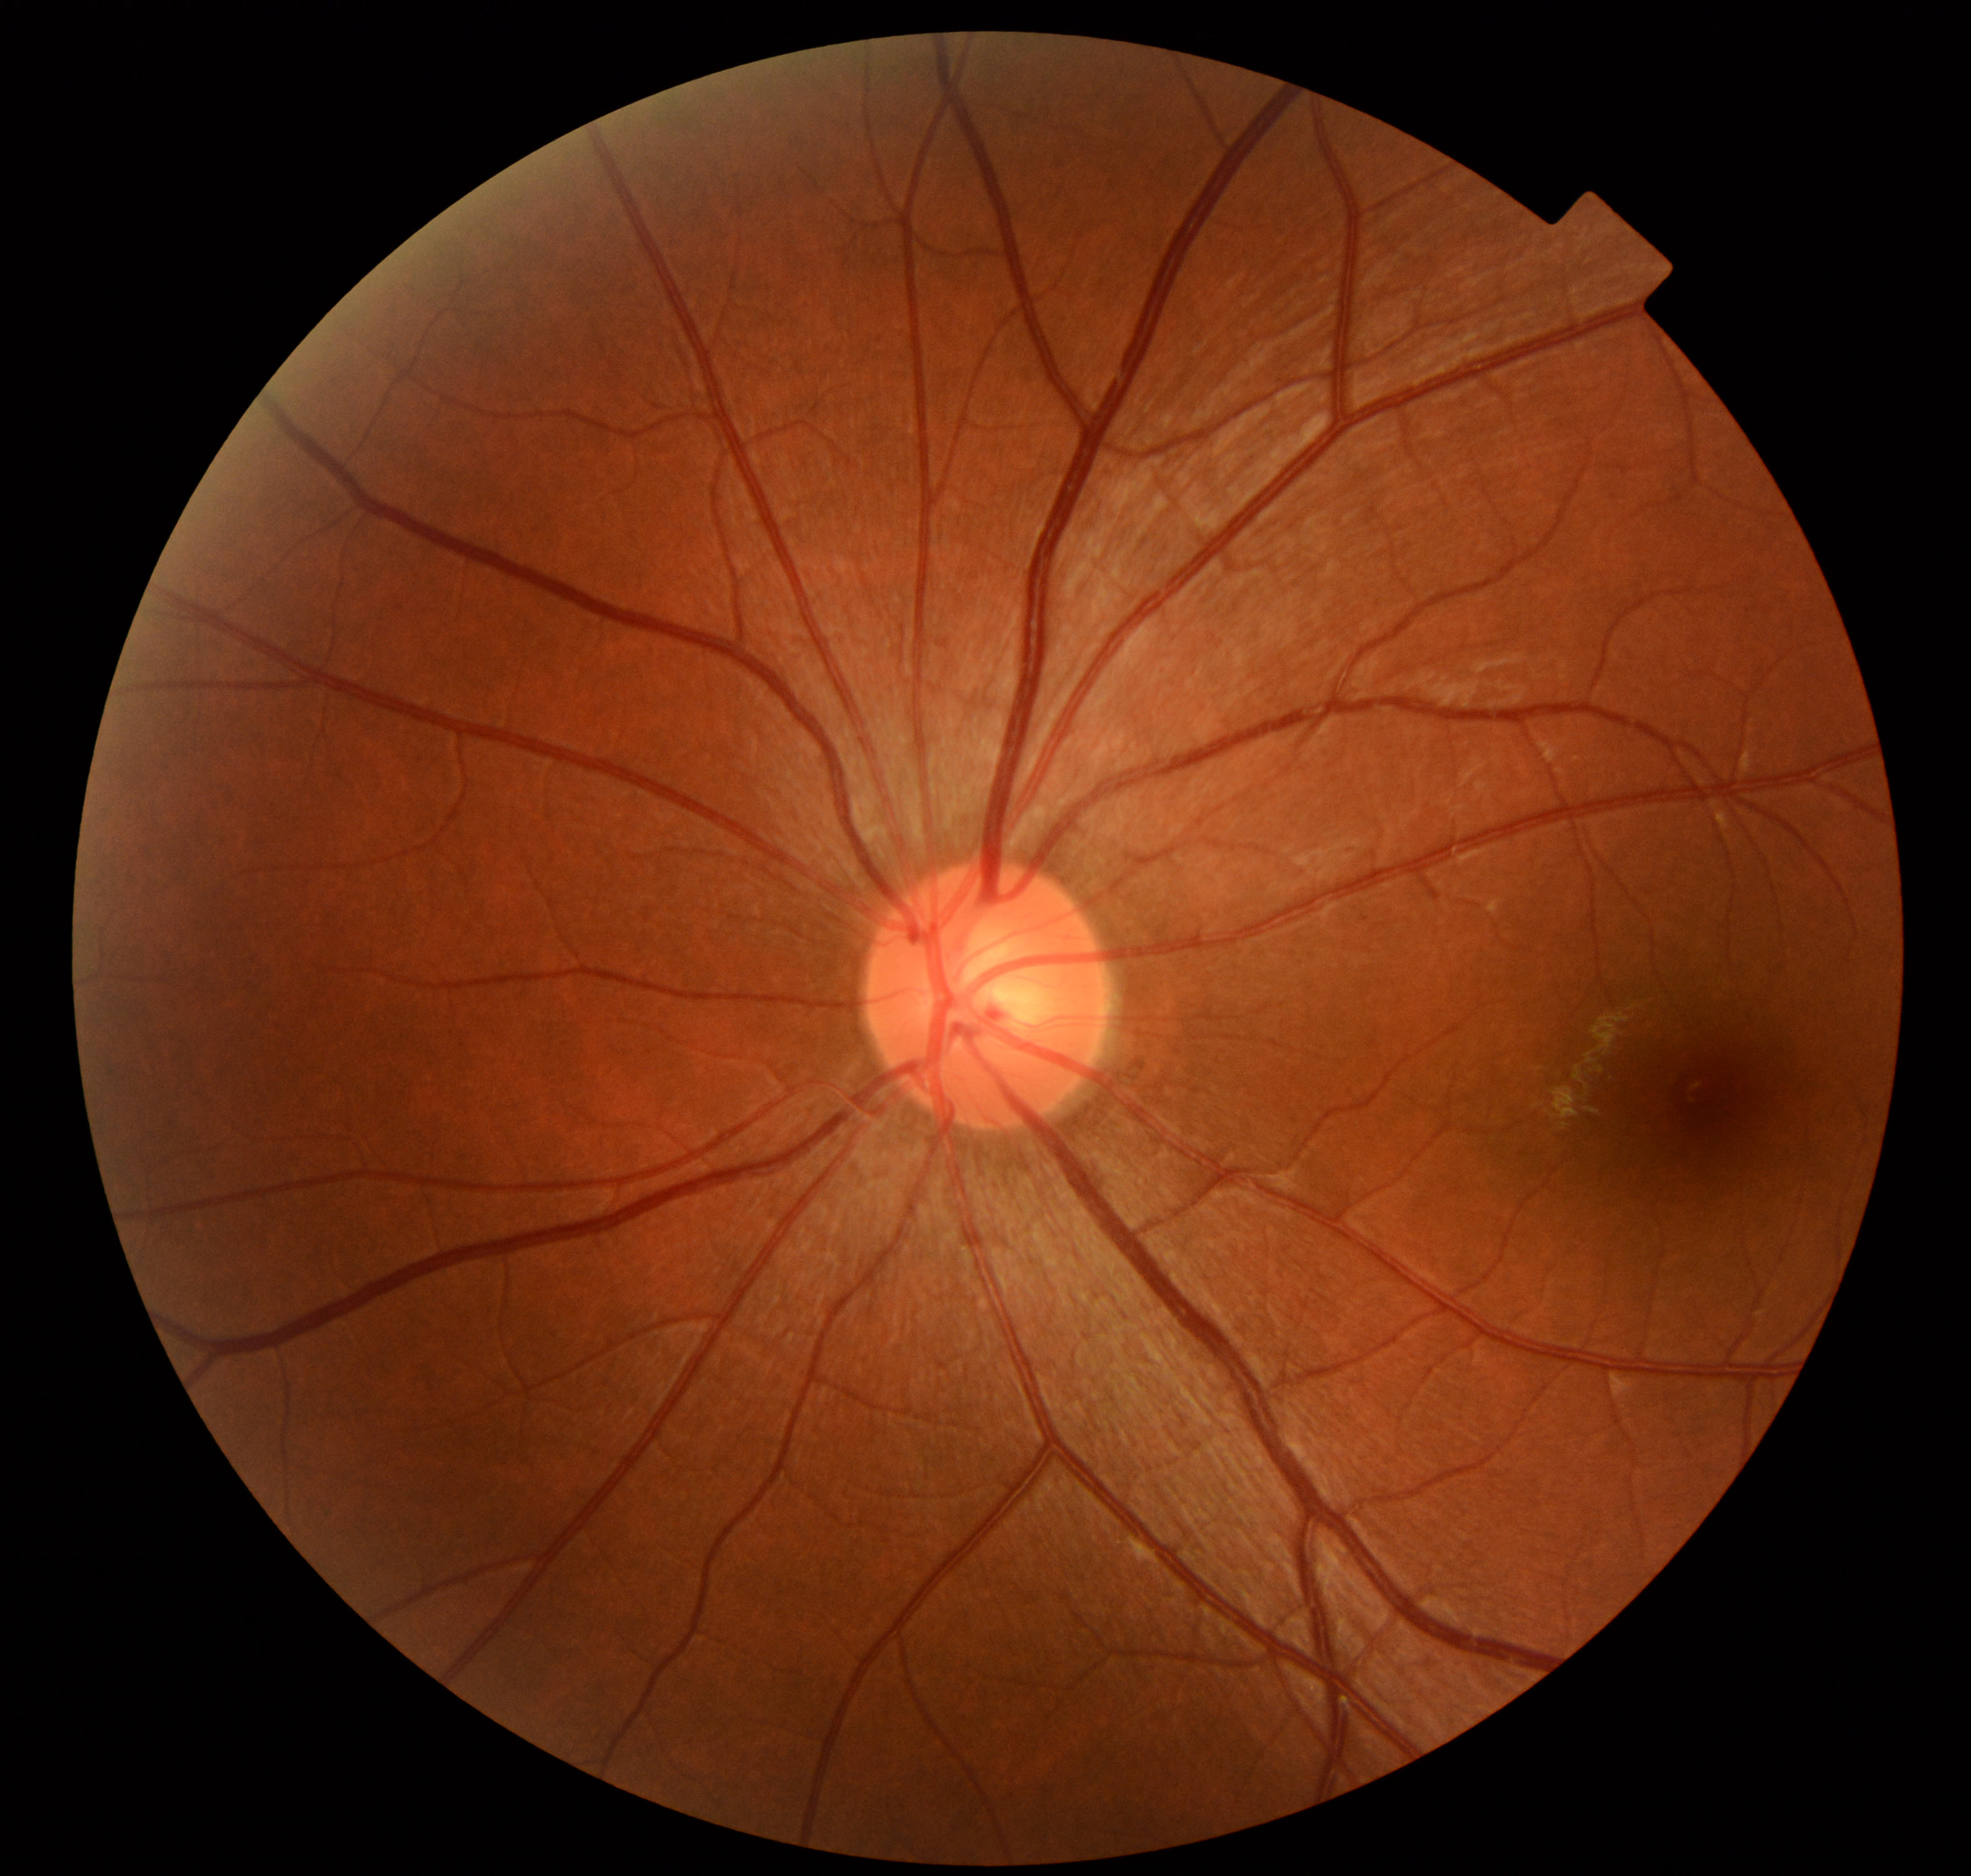 The fundus appears normal with no pathological findings.